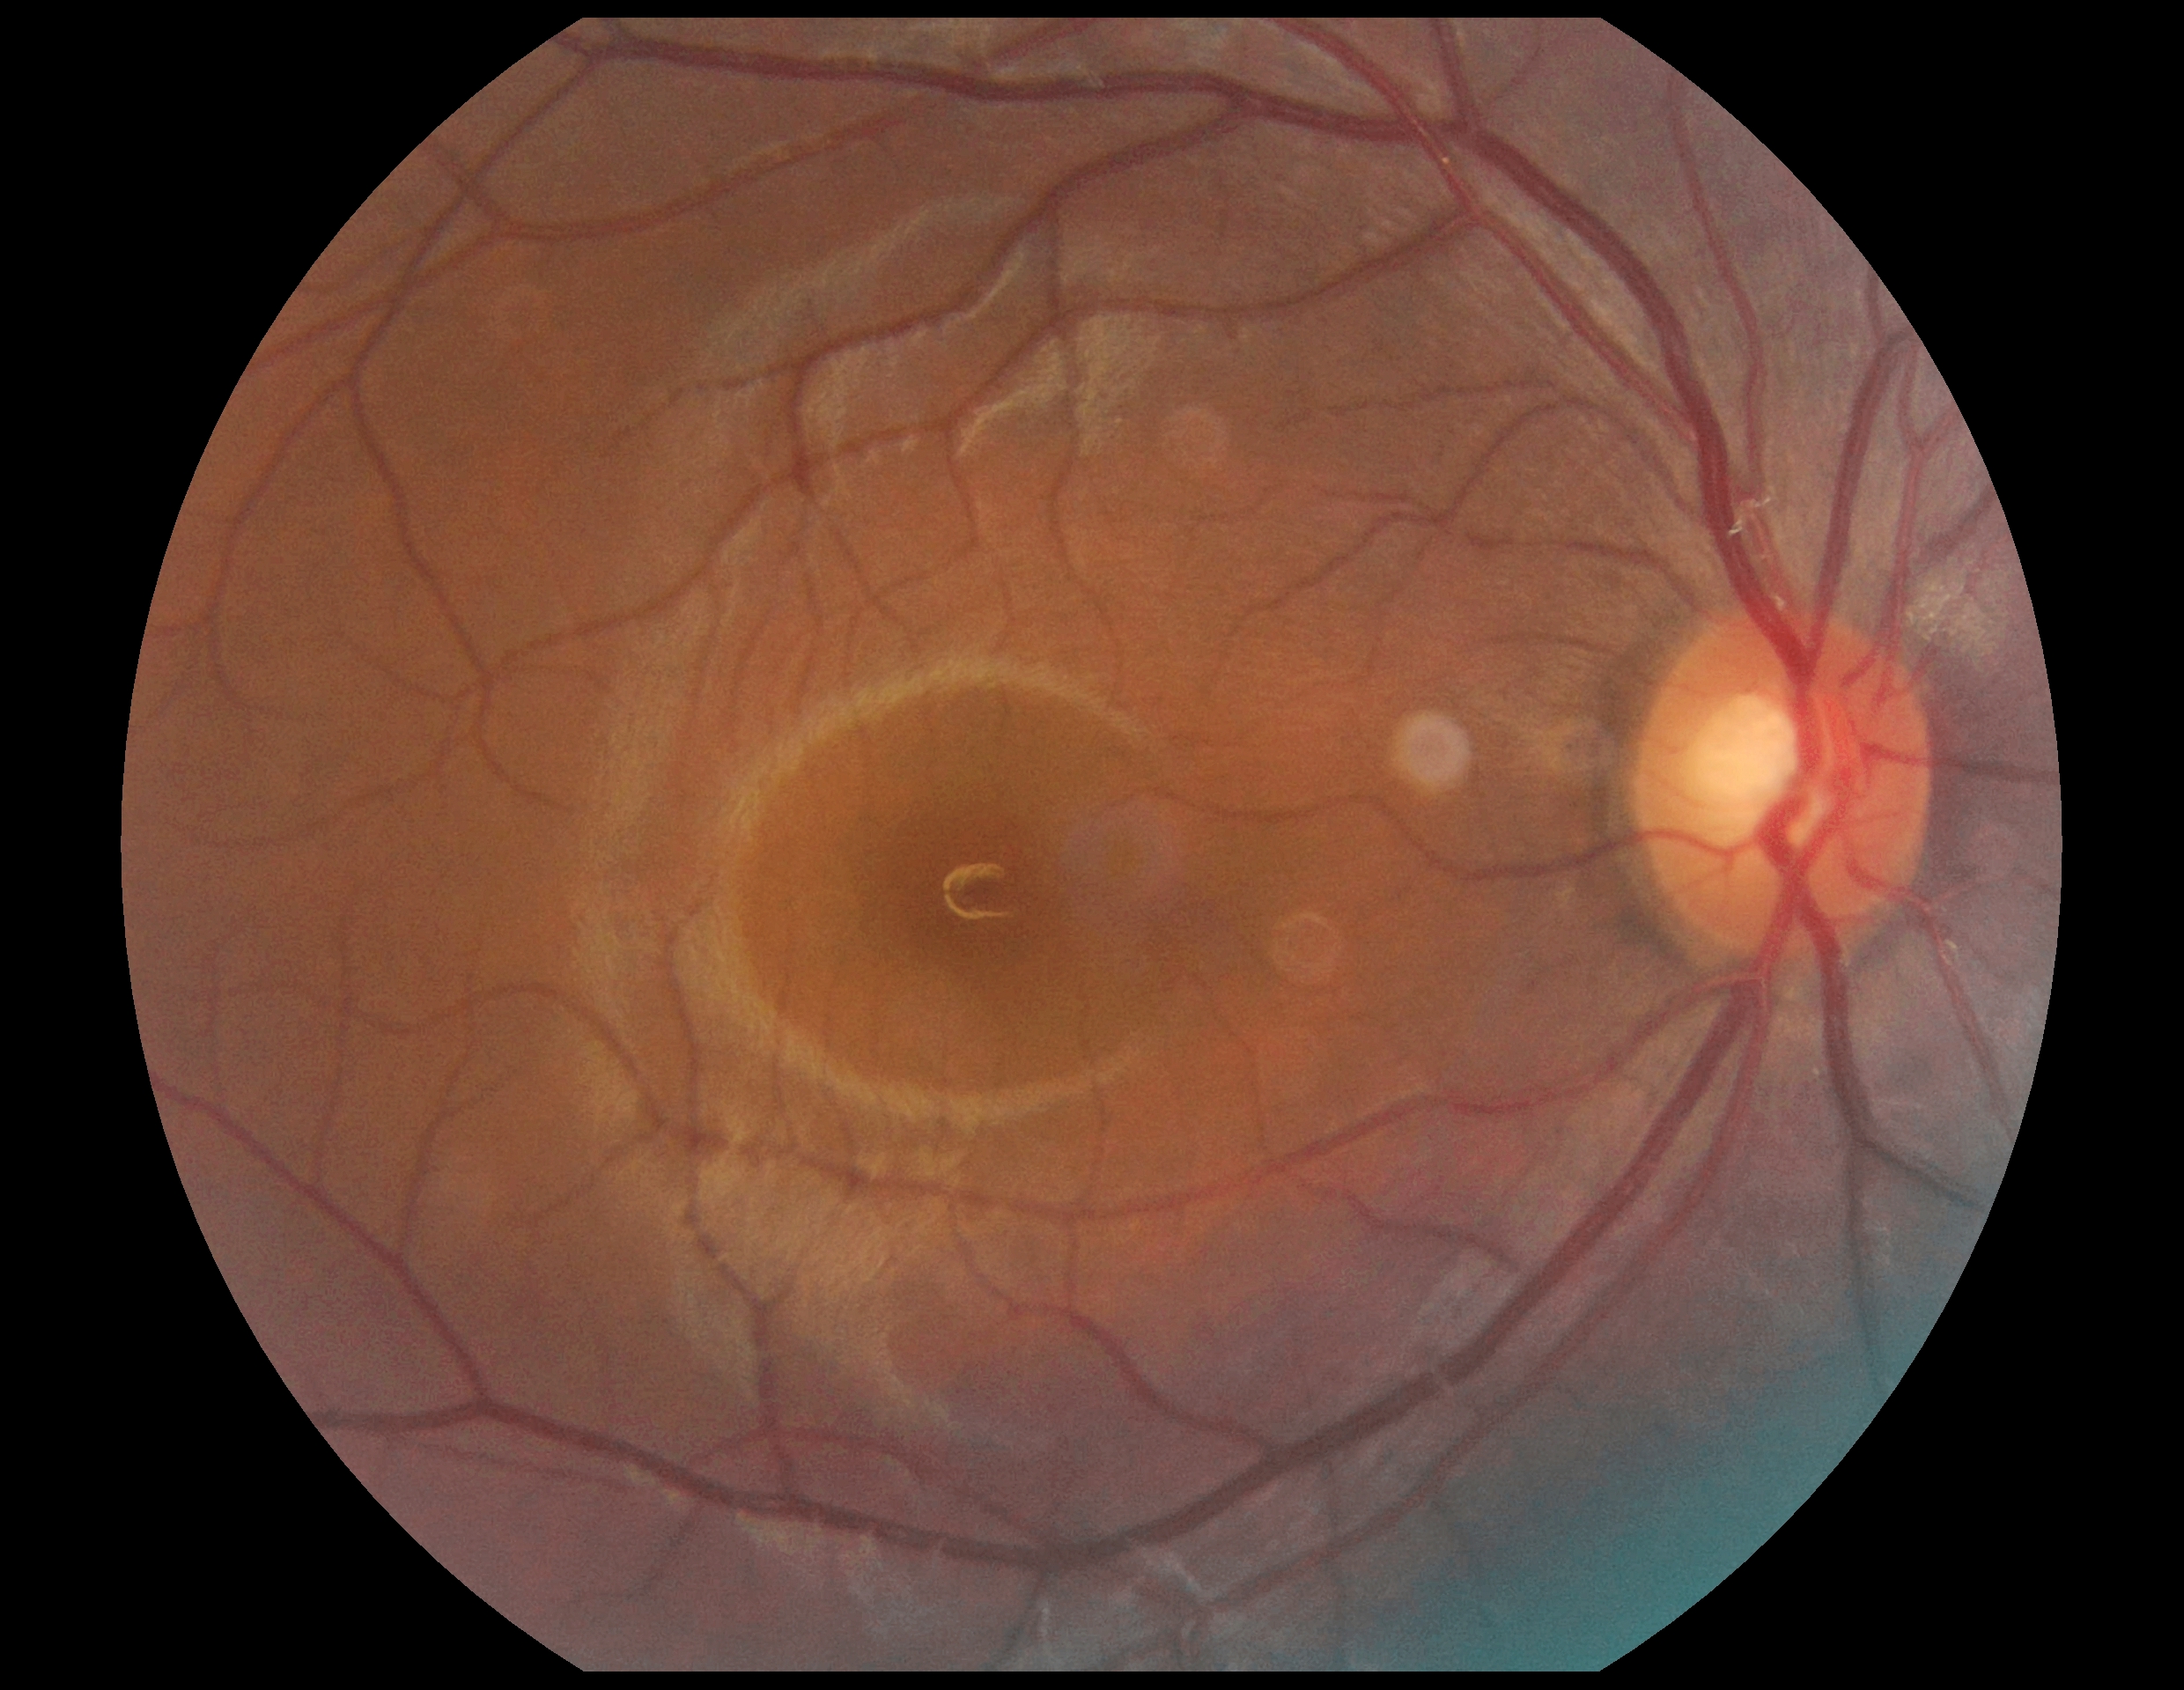

DR severity: no apparent retinopathy (grade 0) — no visible signs of diabetic retinopathy.